Acquired on the Clarity RetCam 3. Wide-field fundus photograph of an infant. Image size 640x480 — 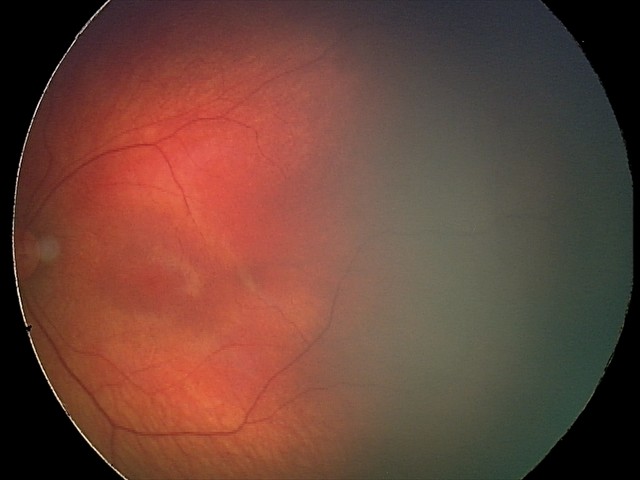 Examination diagnosed as retinal hemorrhages.